Camera: Clarity RetCam 3 (130° FOV); wide-field fundus image from infant ROP screening; 640x480px
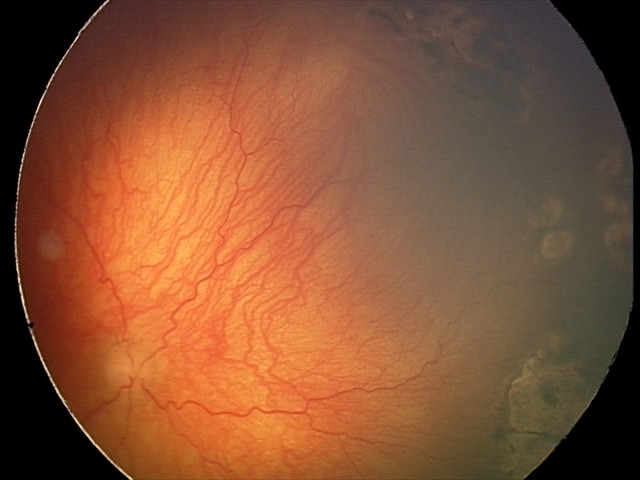 Plus disease = present — abnormal dilation and tortuosity of the posterior pole retinal vessels; diagnosis = A-ROP (aggressive ROP) — rapidly progressive severe ROP with prominent plus disease, often without classic stage progression.